Davis DR grading.
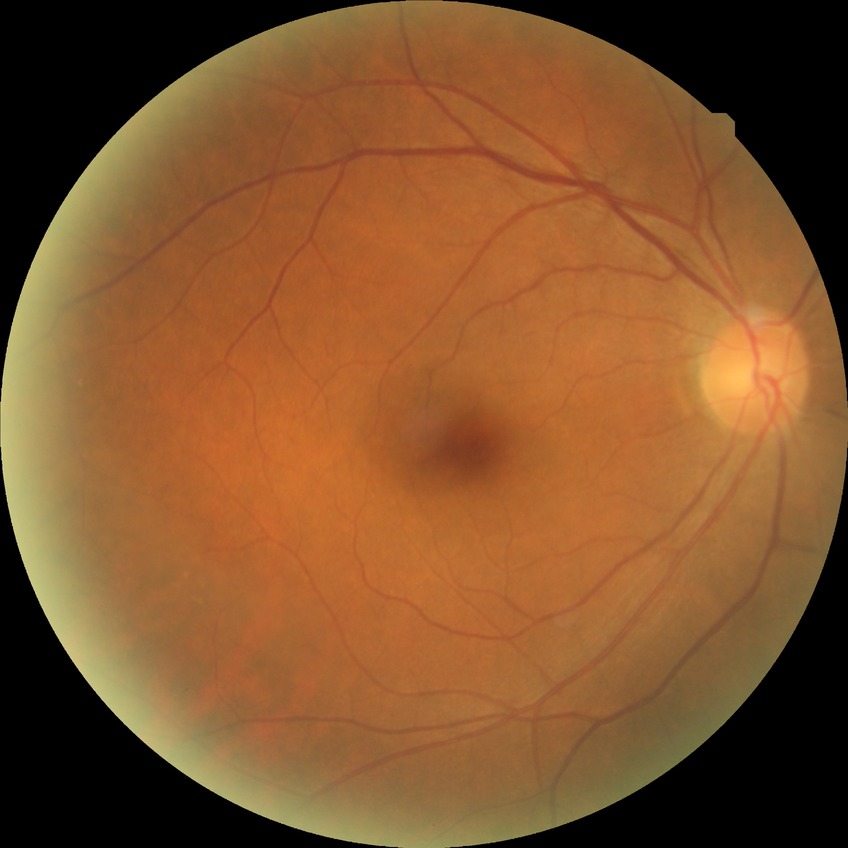 Retinopathy stage: no diabetic retinopathy.